Captured after pupil dilation · posterior pole field covering the optic disc and macula · color fundus image · FOV: 50 degrees: 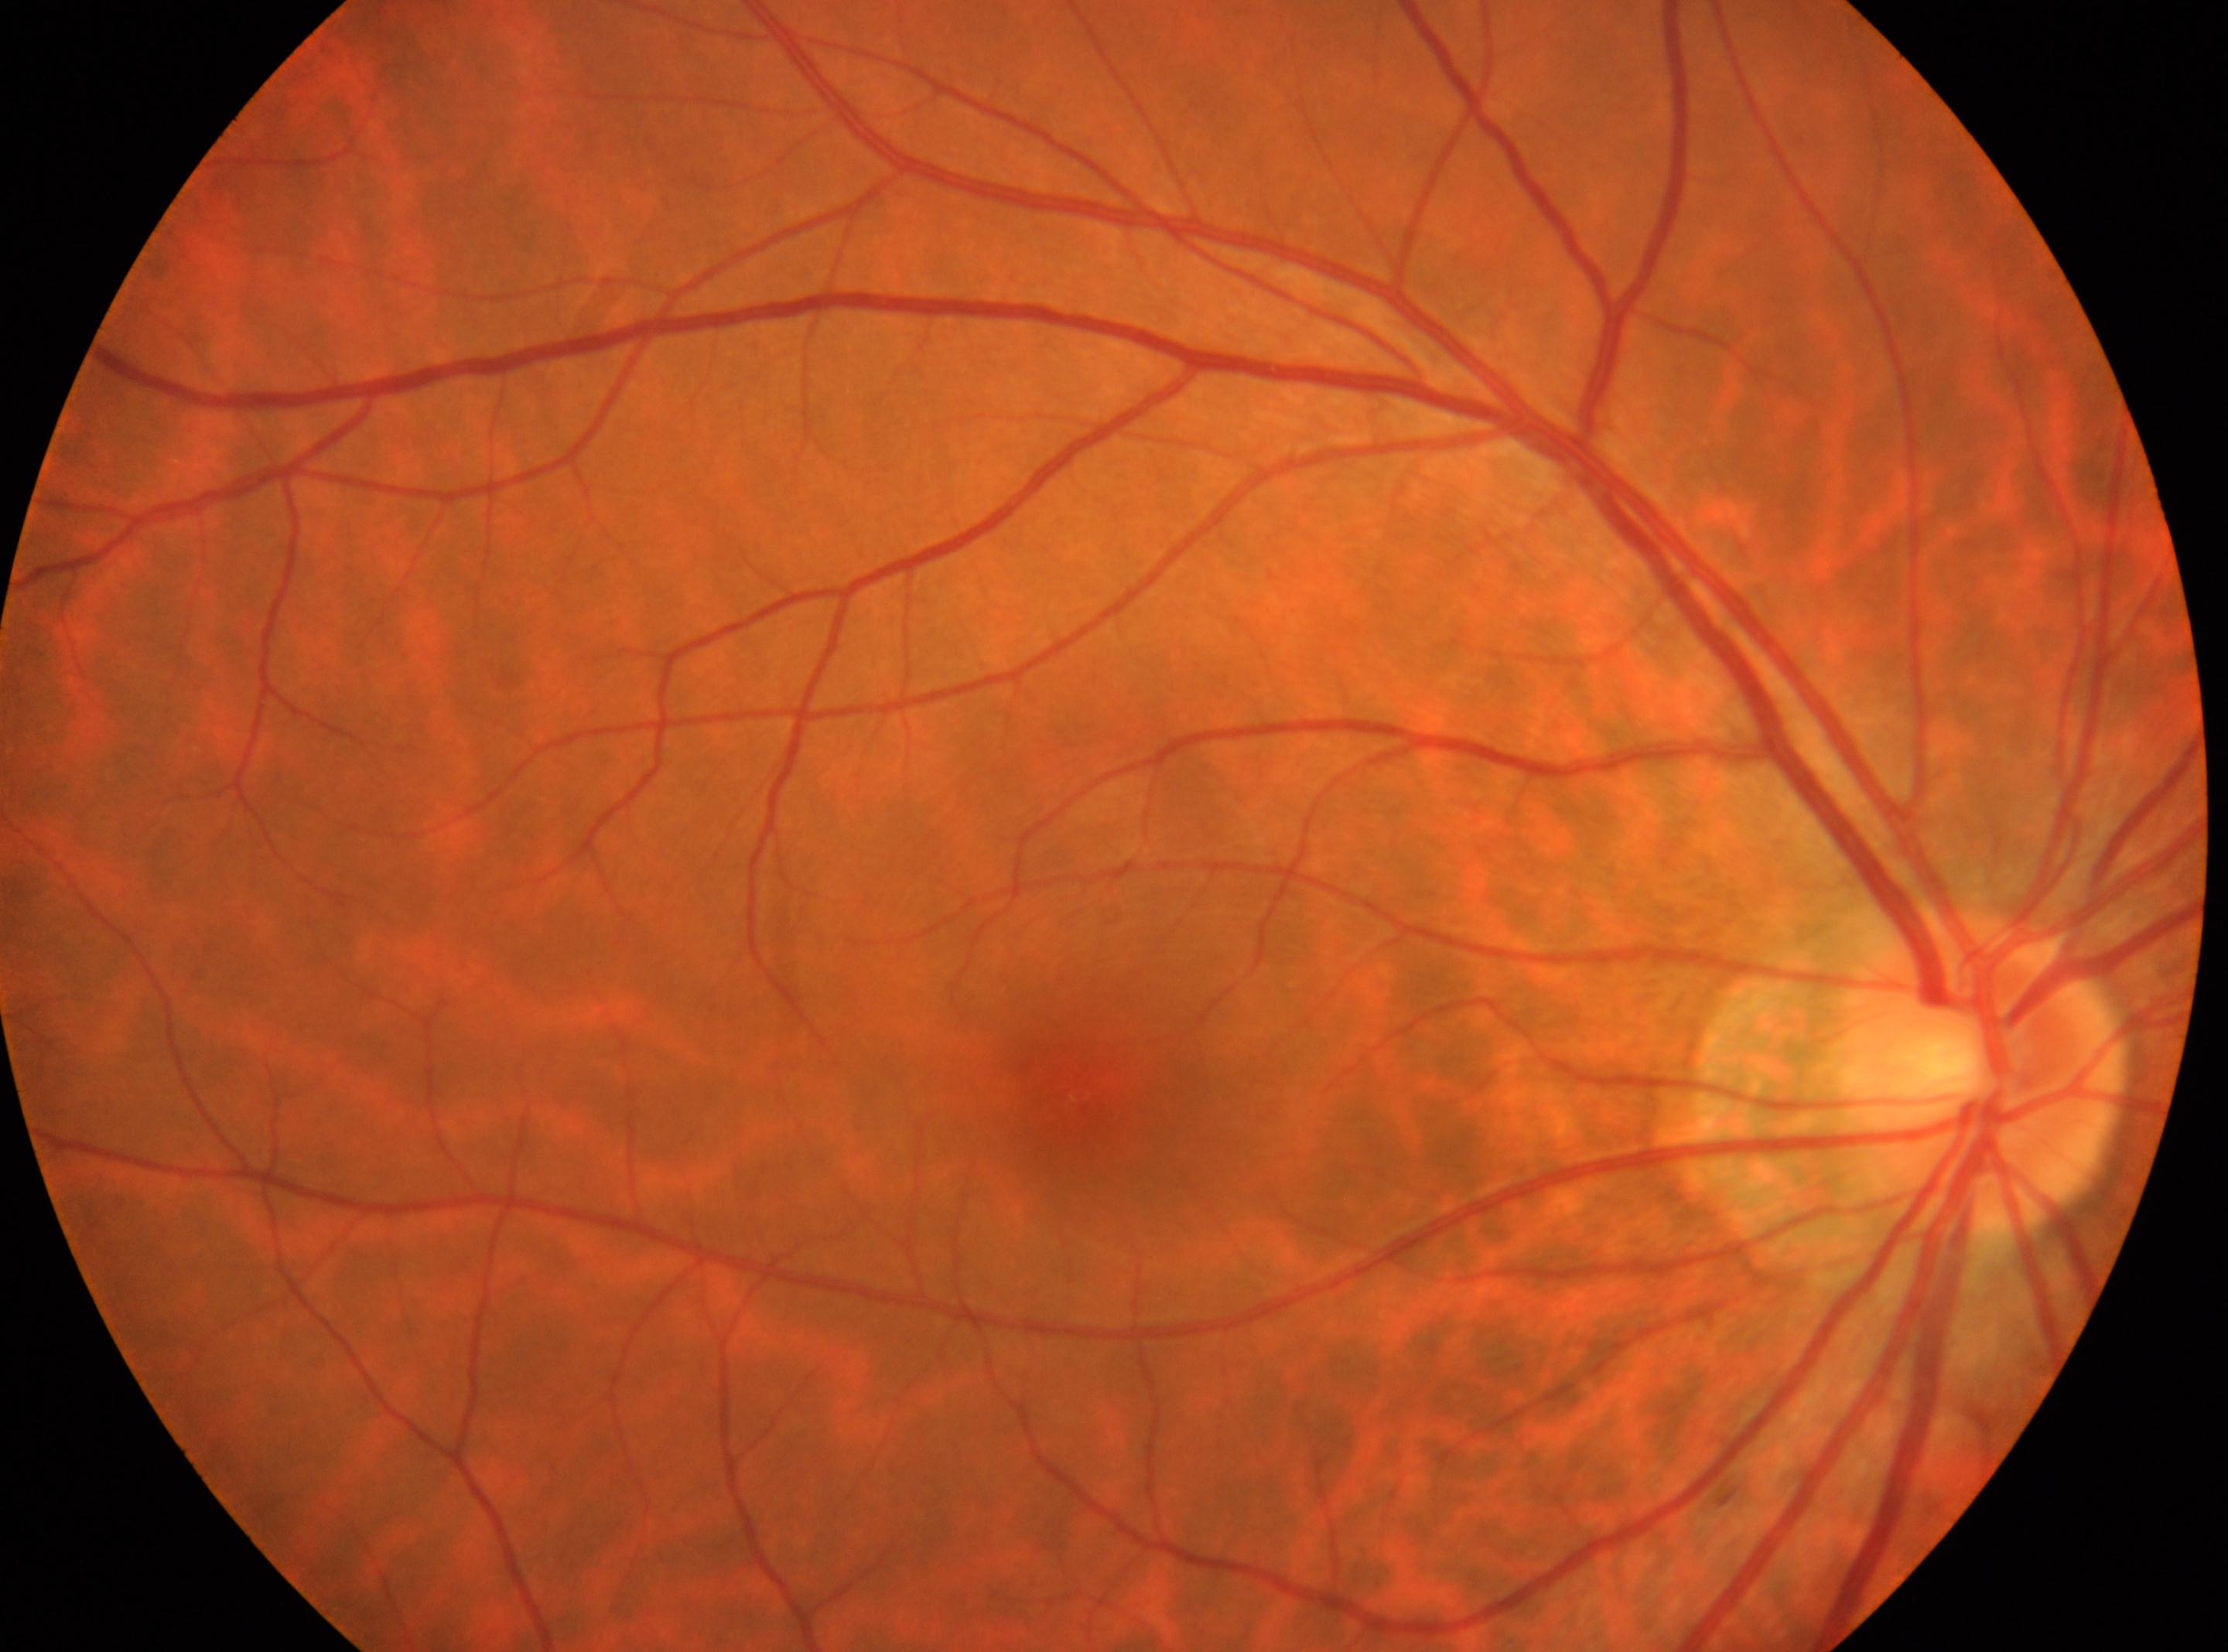
Annotations:
- diabetic retinopathy (DR) — grade 0 (no apparent retinopathy)
- macula center — (x: 1085, y: 1095)
- laterality — right
- DR impression — No diabetic retinopathy identified
- optic nerve head — (x: 1980, y: 1074)